848 by 848 pixels · diabetic retinopathy graded by the modified Davis classification — 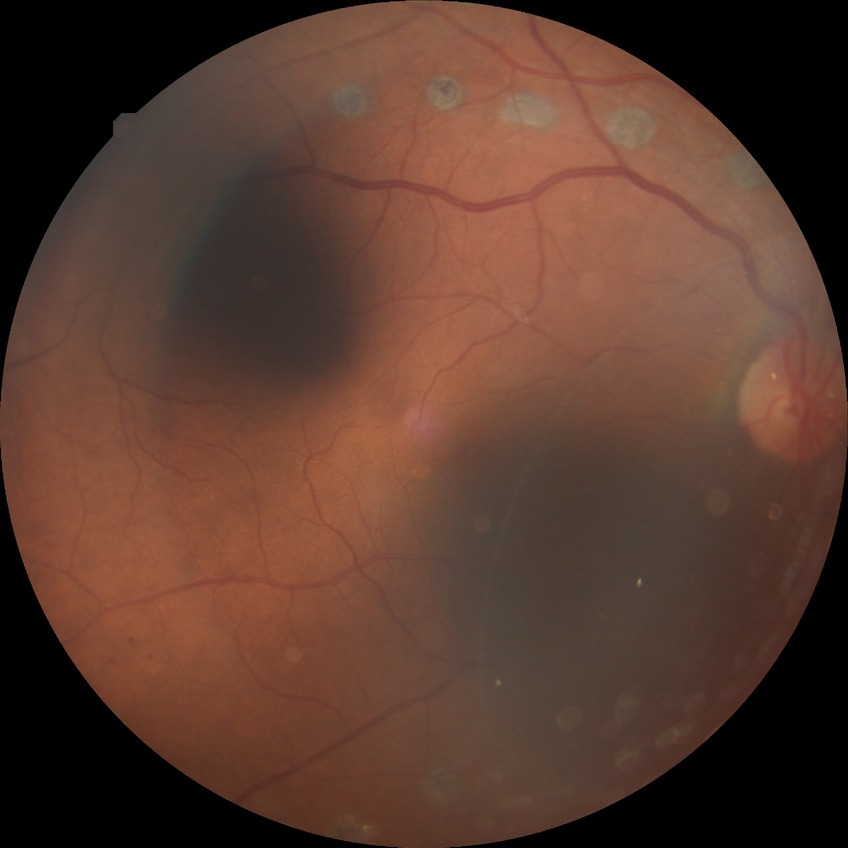

{"davis_grade": "proliferative diabetic retinopathy"}